RetCam wide-field infant fundus image
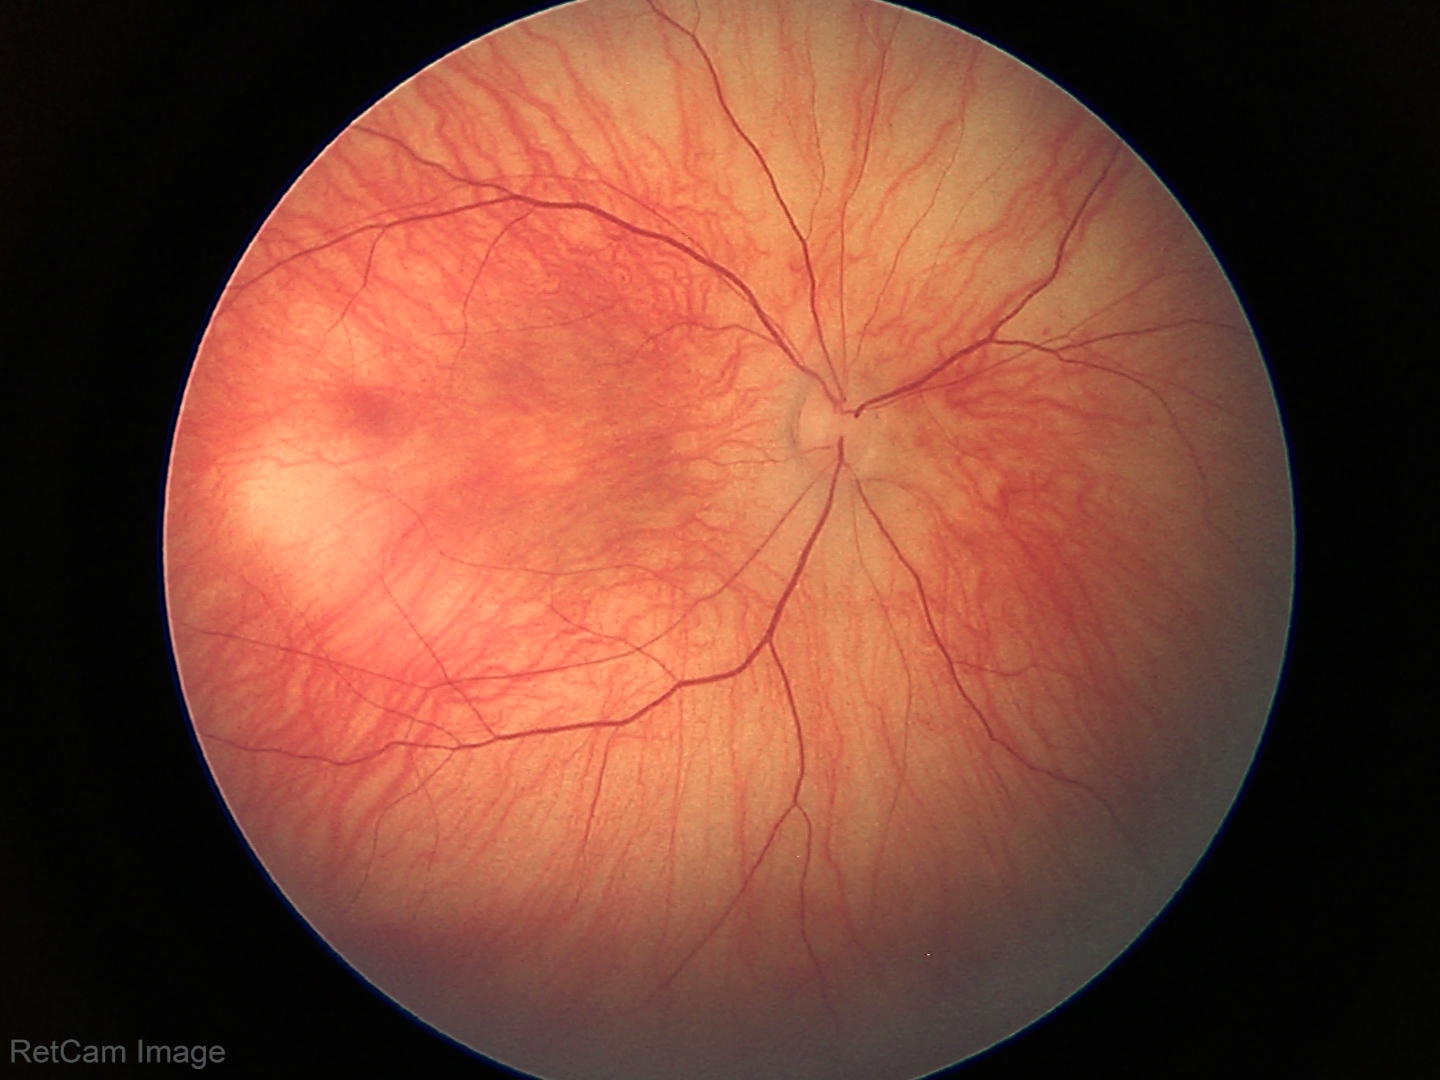 Screening examination with no abnormal retinal findings.